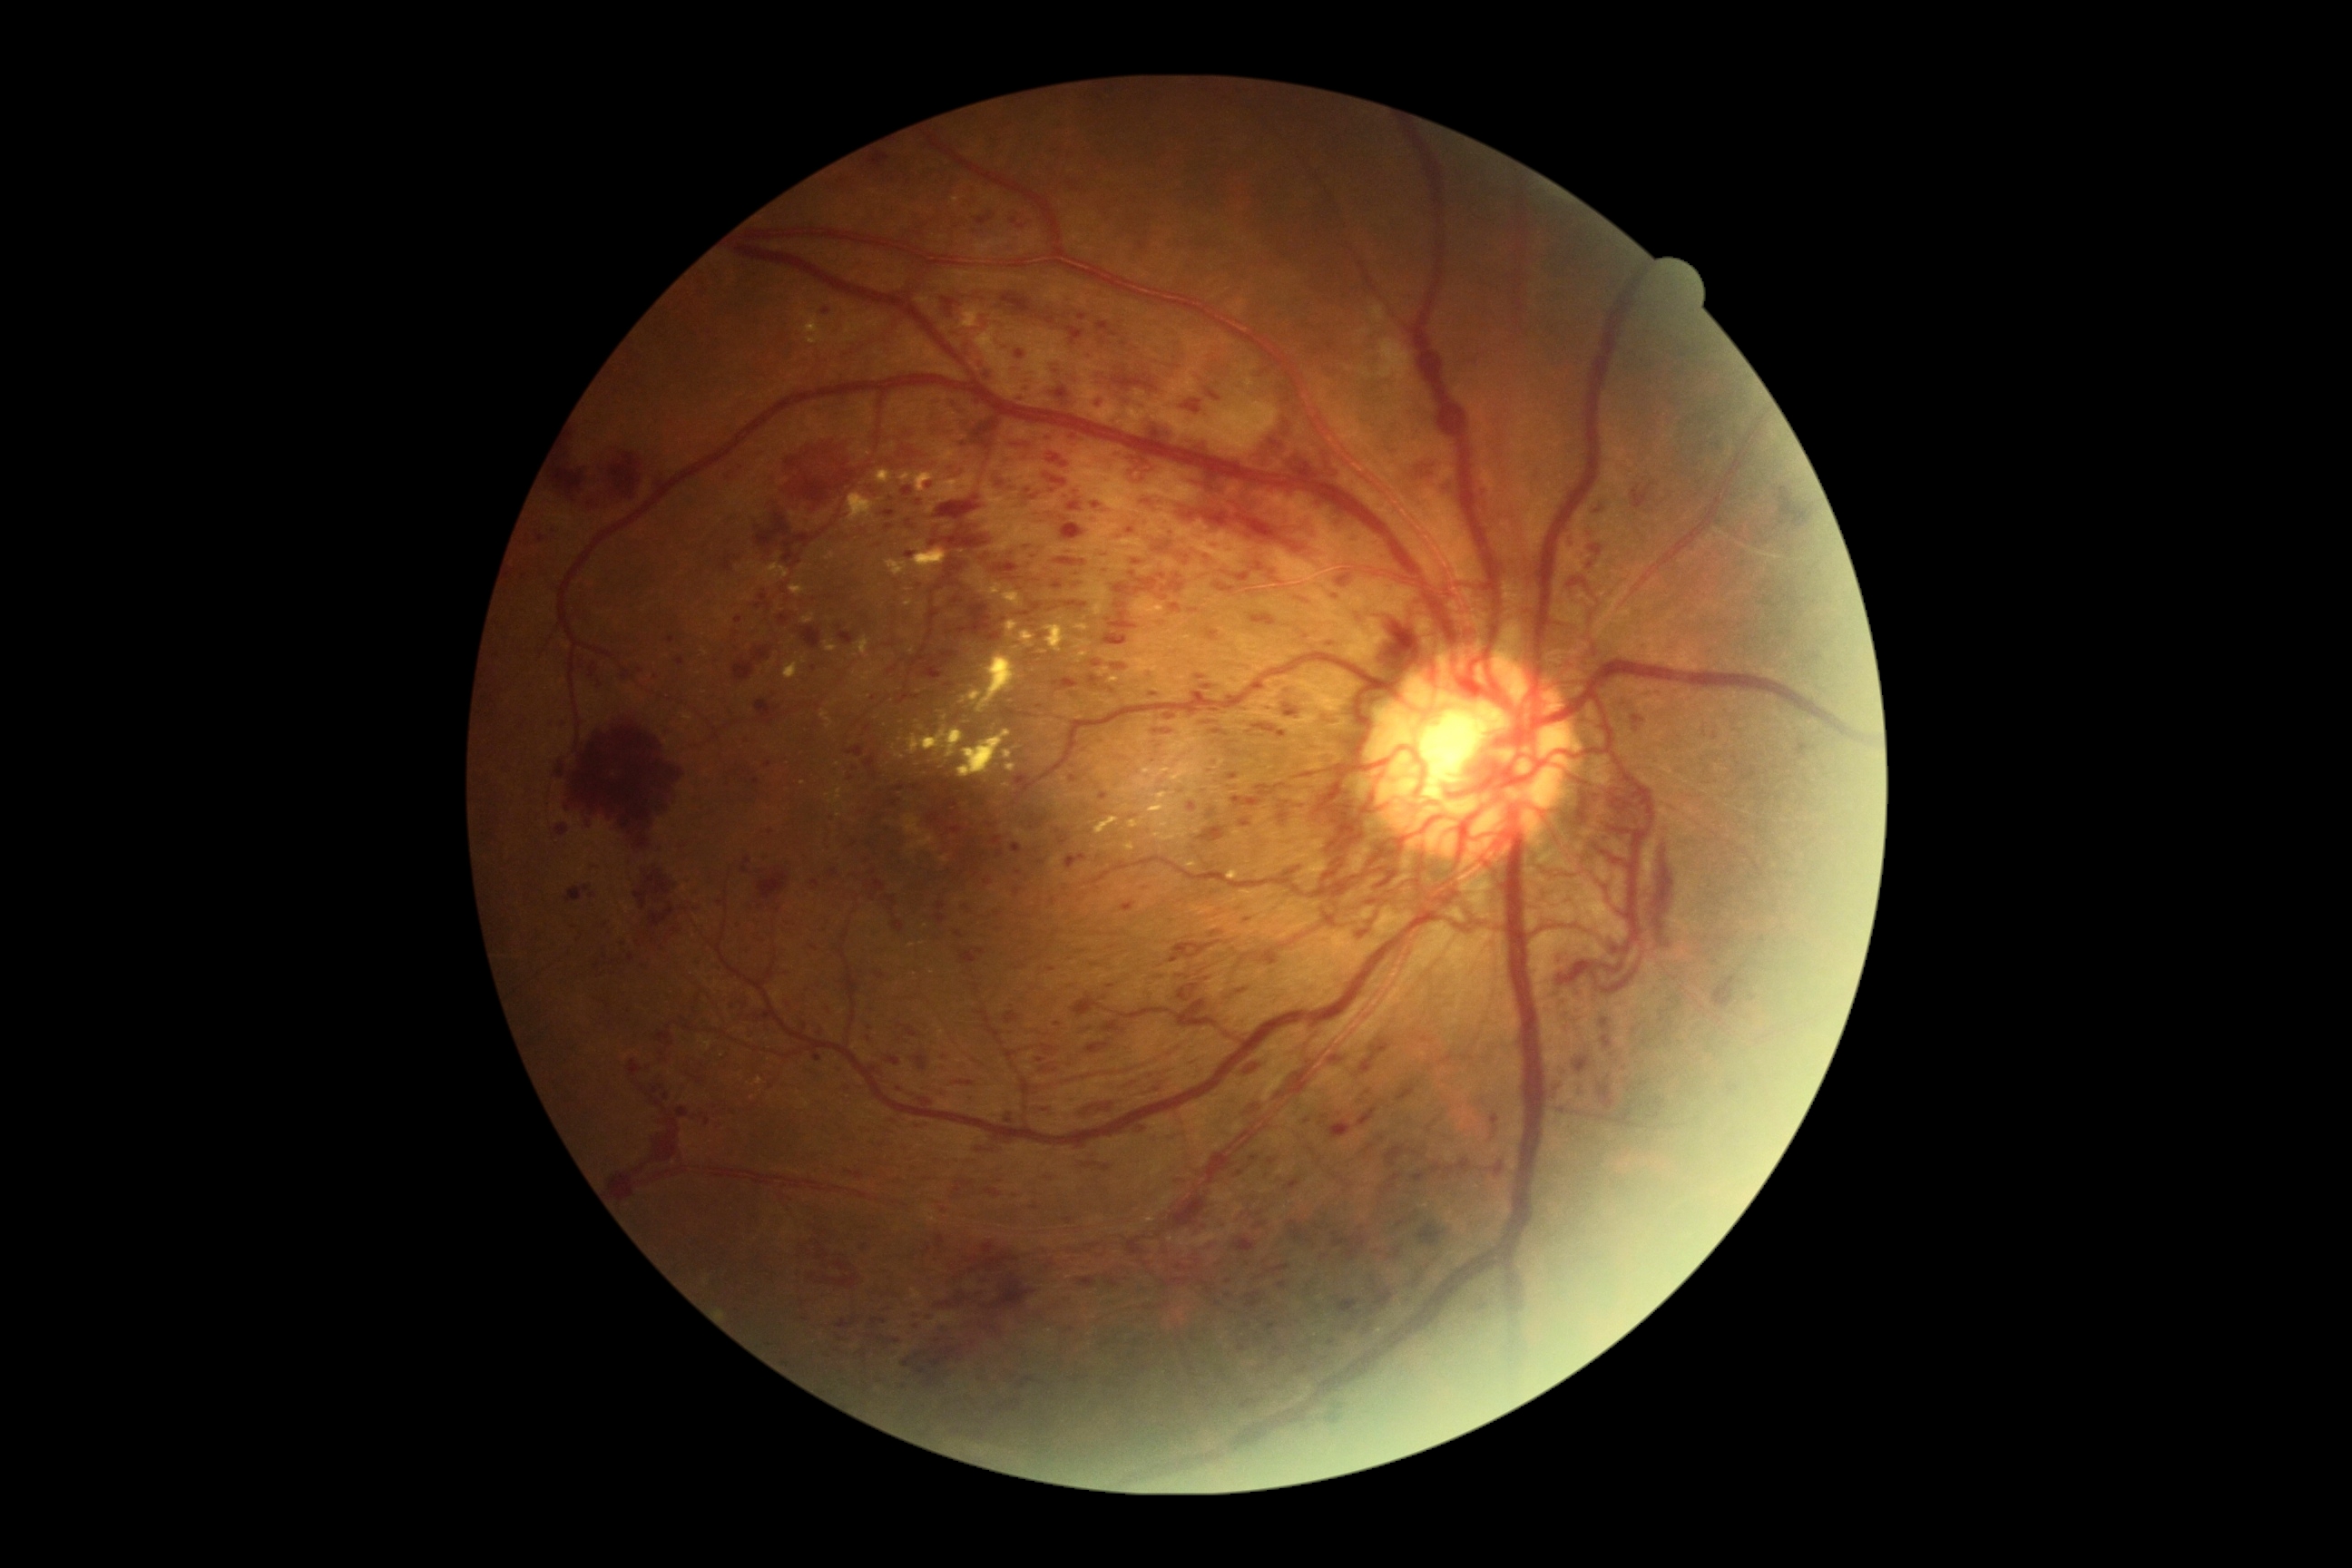 Diabetic retinopathy (DR) is PDR (grade 4). Hemorrhages (HEs) include lesions at <region>1046, 1177, 1054, 1181</region> | <region>1197, 674, 1208, 680</region> | <region>908, 1084, 939, 1102</region> | <region>1048, 453, 1070, 469</region> | <region>1104, 687, 1115, 694</region> | <region>981, 1273, 1037, 1313</region> | <region>1171, 941, 1200, 950</region> | <region>756, 867, 790, 905</region> | <region>1166, 709, 1230, 721</region> | <region>868, 1335, 876, 1340</region> | <region>1208, 932, 1220, 939</region> | <region>1054, 387, 1070, 400</region> | <region>836, 625, 856, 647</region> | <region>678, 1106, 691, 1115</region> | <region>1246, 1291, 1262, 1309</region> | <region>721, 556, 732, 573</region> | <region>741, 858, 750, 874</region>. Small HEs near (734; 772) | (1630; 1090).